Intraocular pressure (IOP) (non-contact tonometry): 15 mmHg · gender: F · non-mydriatic acquisition: 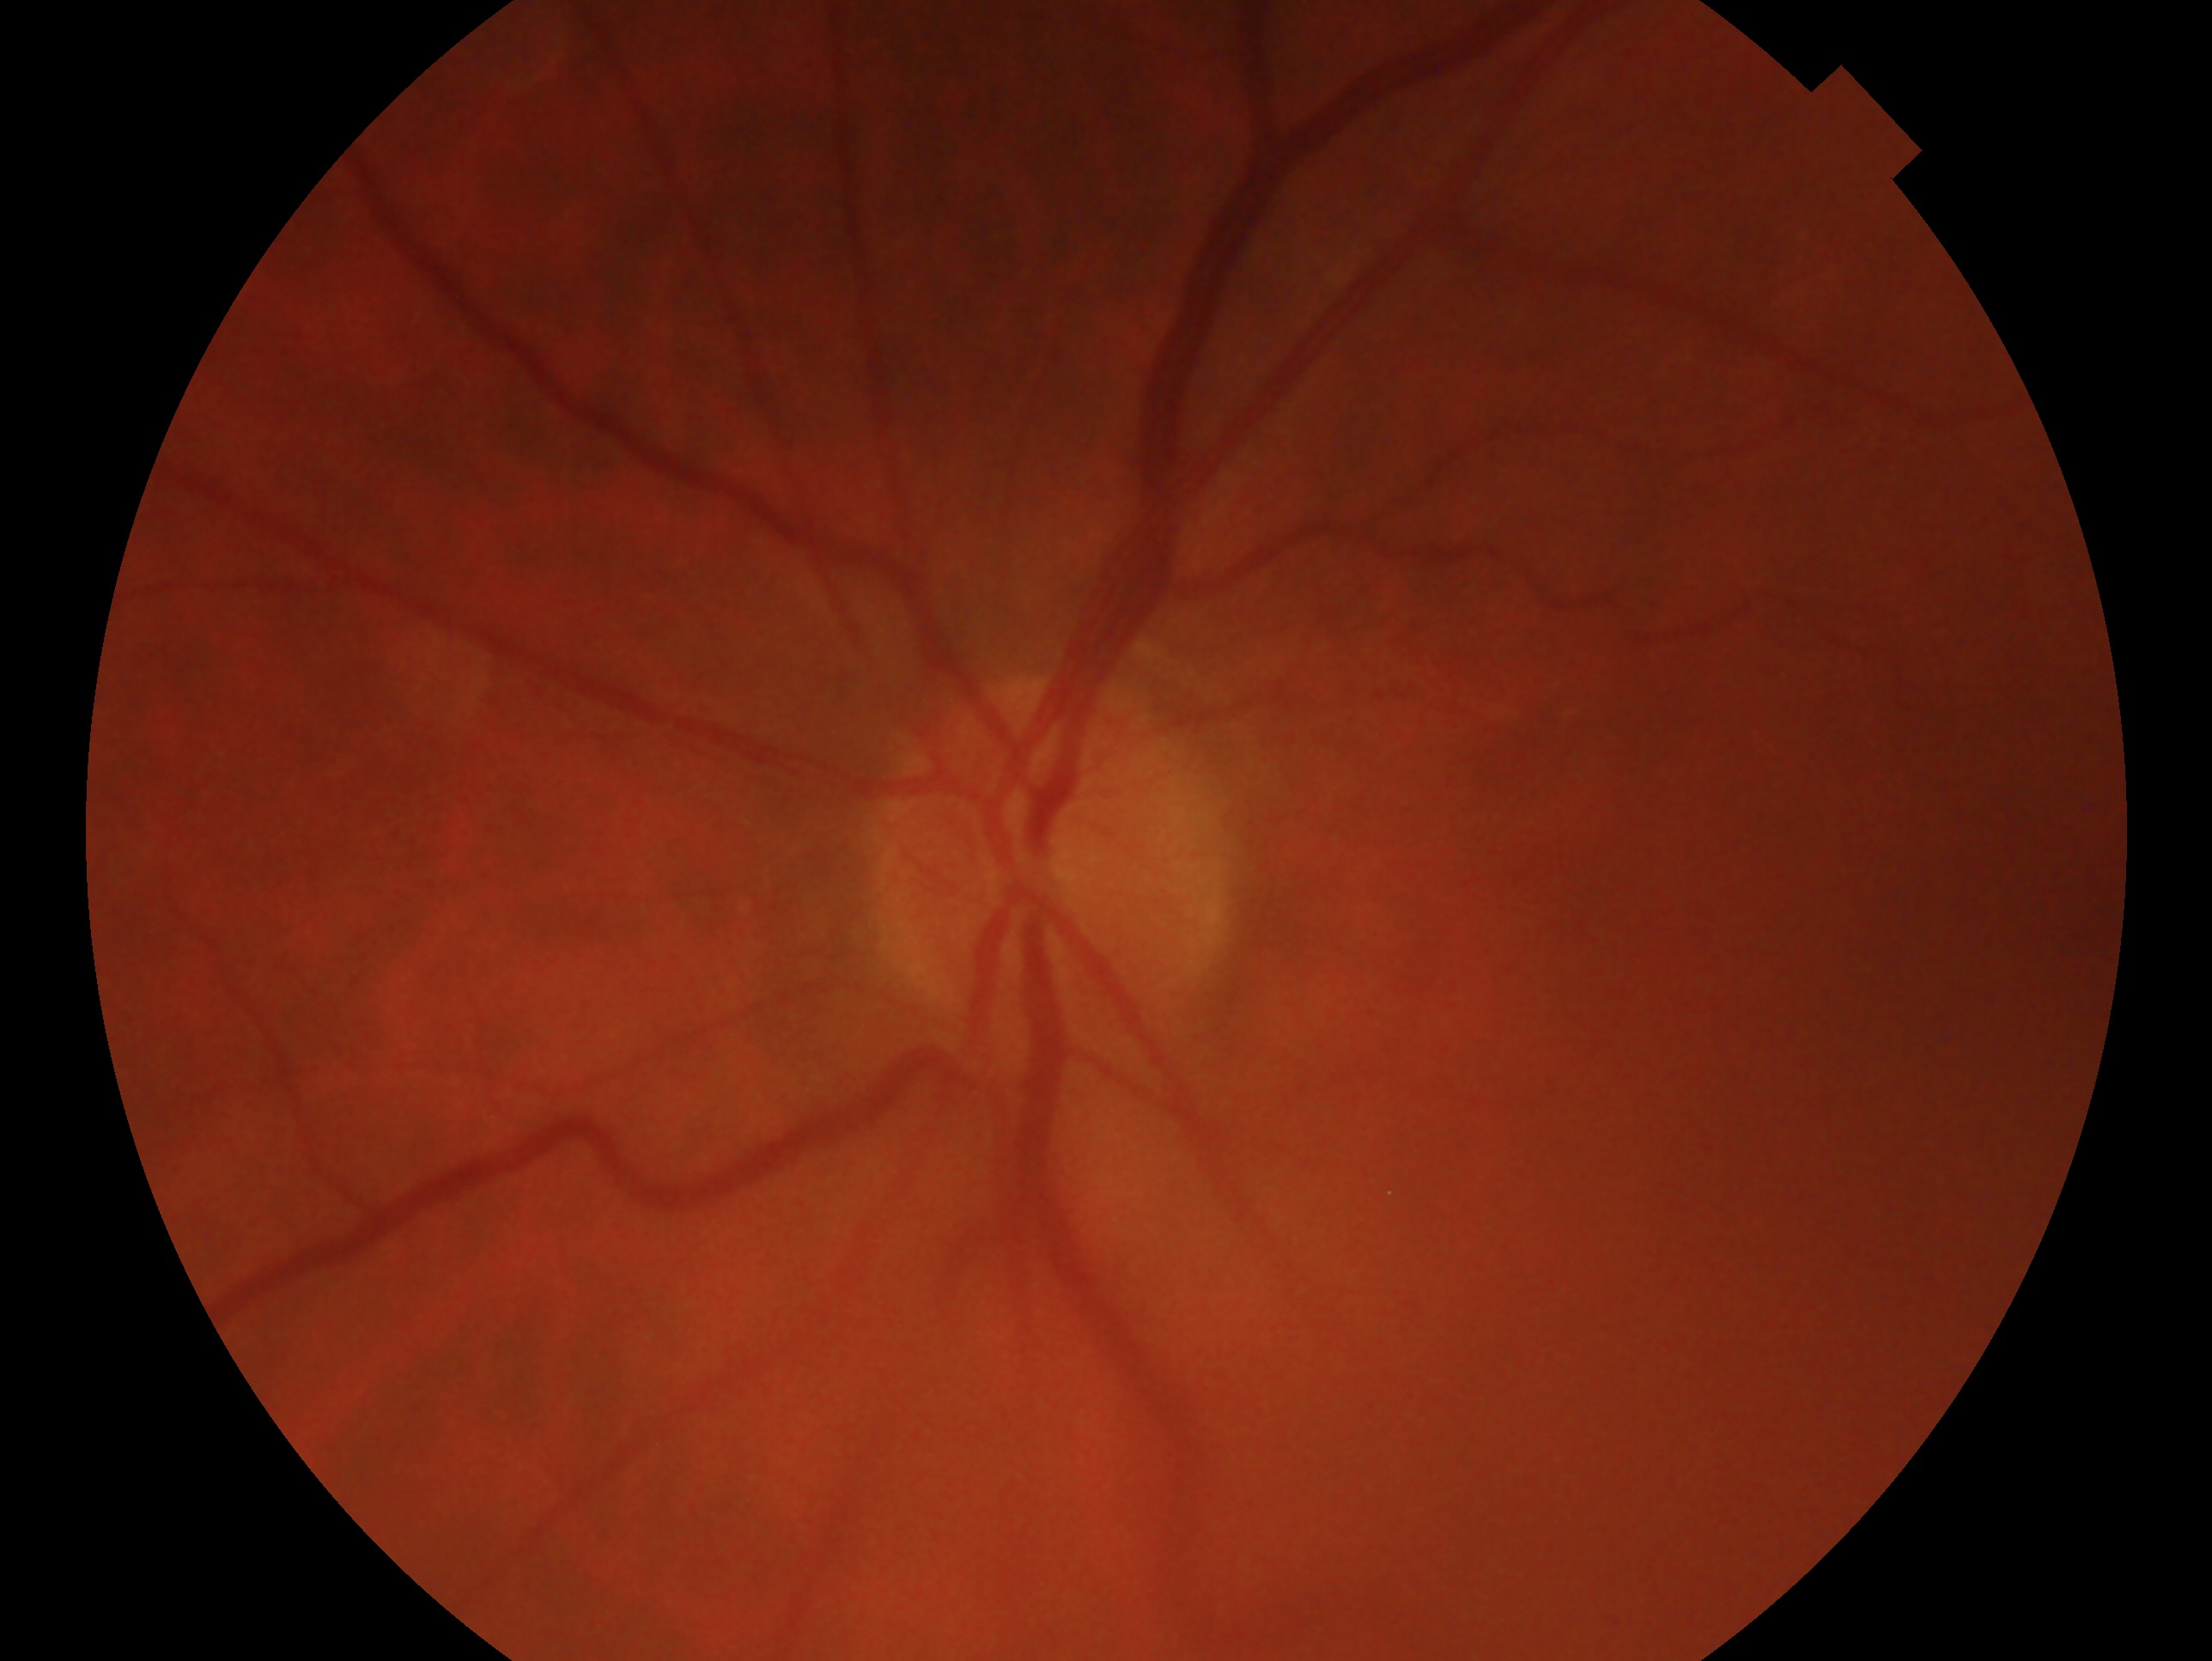 diagnosis: negative for glaucoma; eye: OS.